Image size 2352x1568. Retinal fundus photograph:
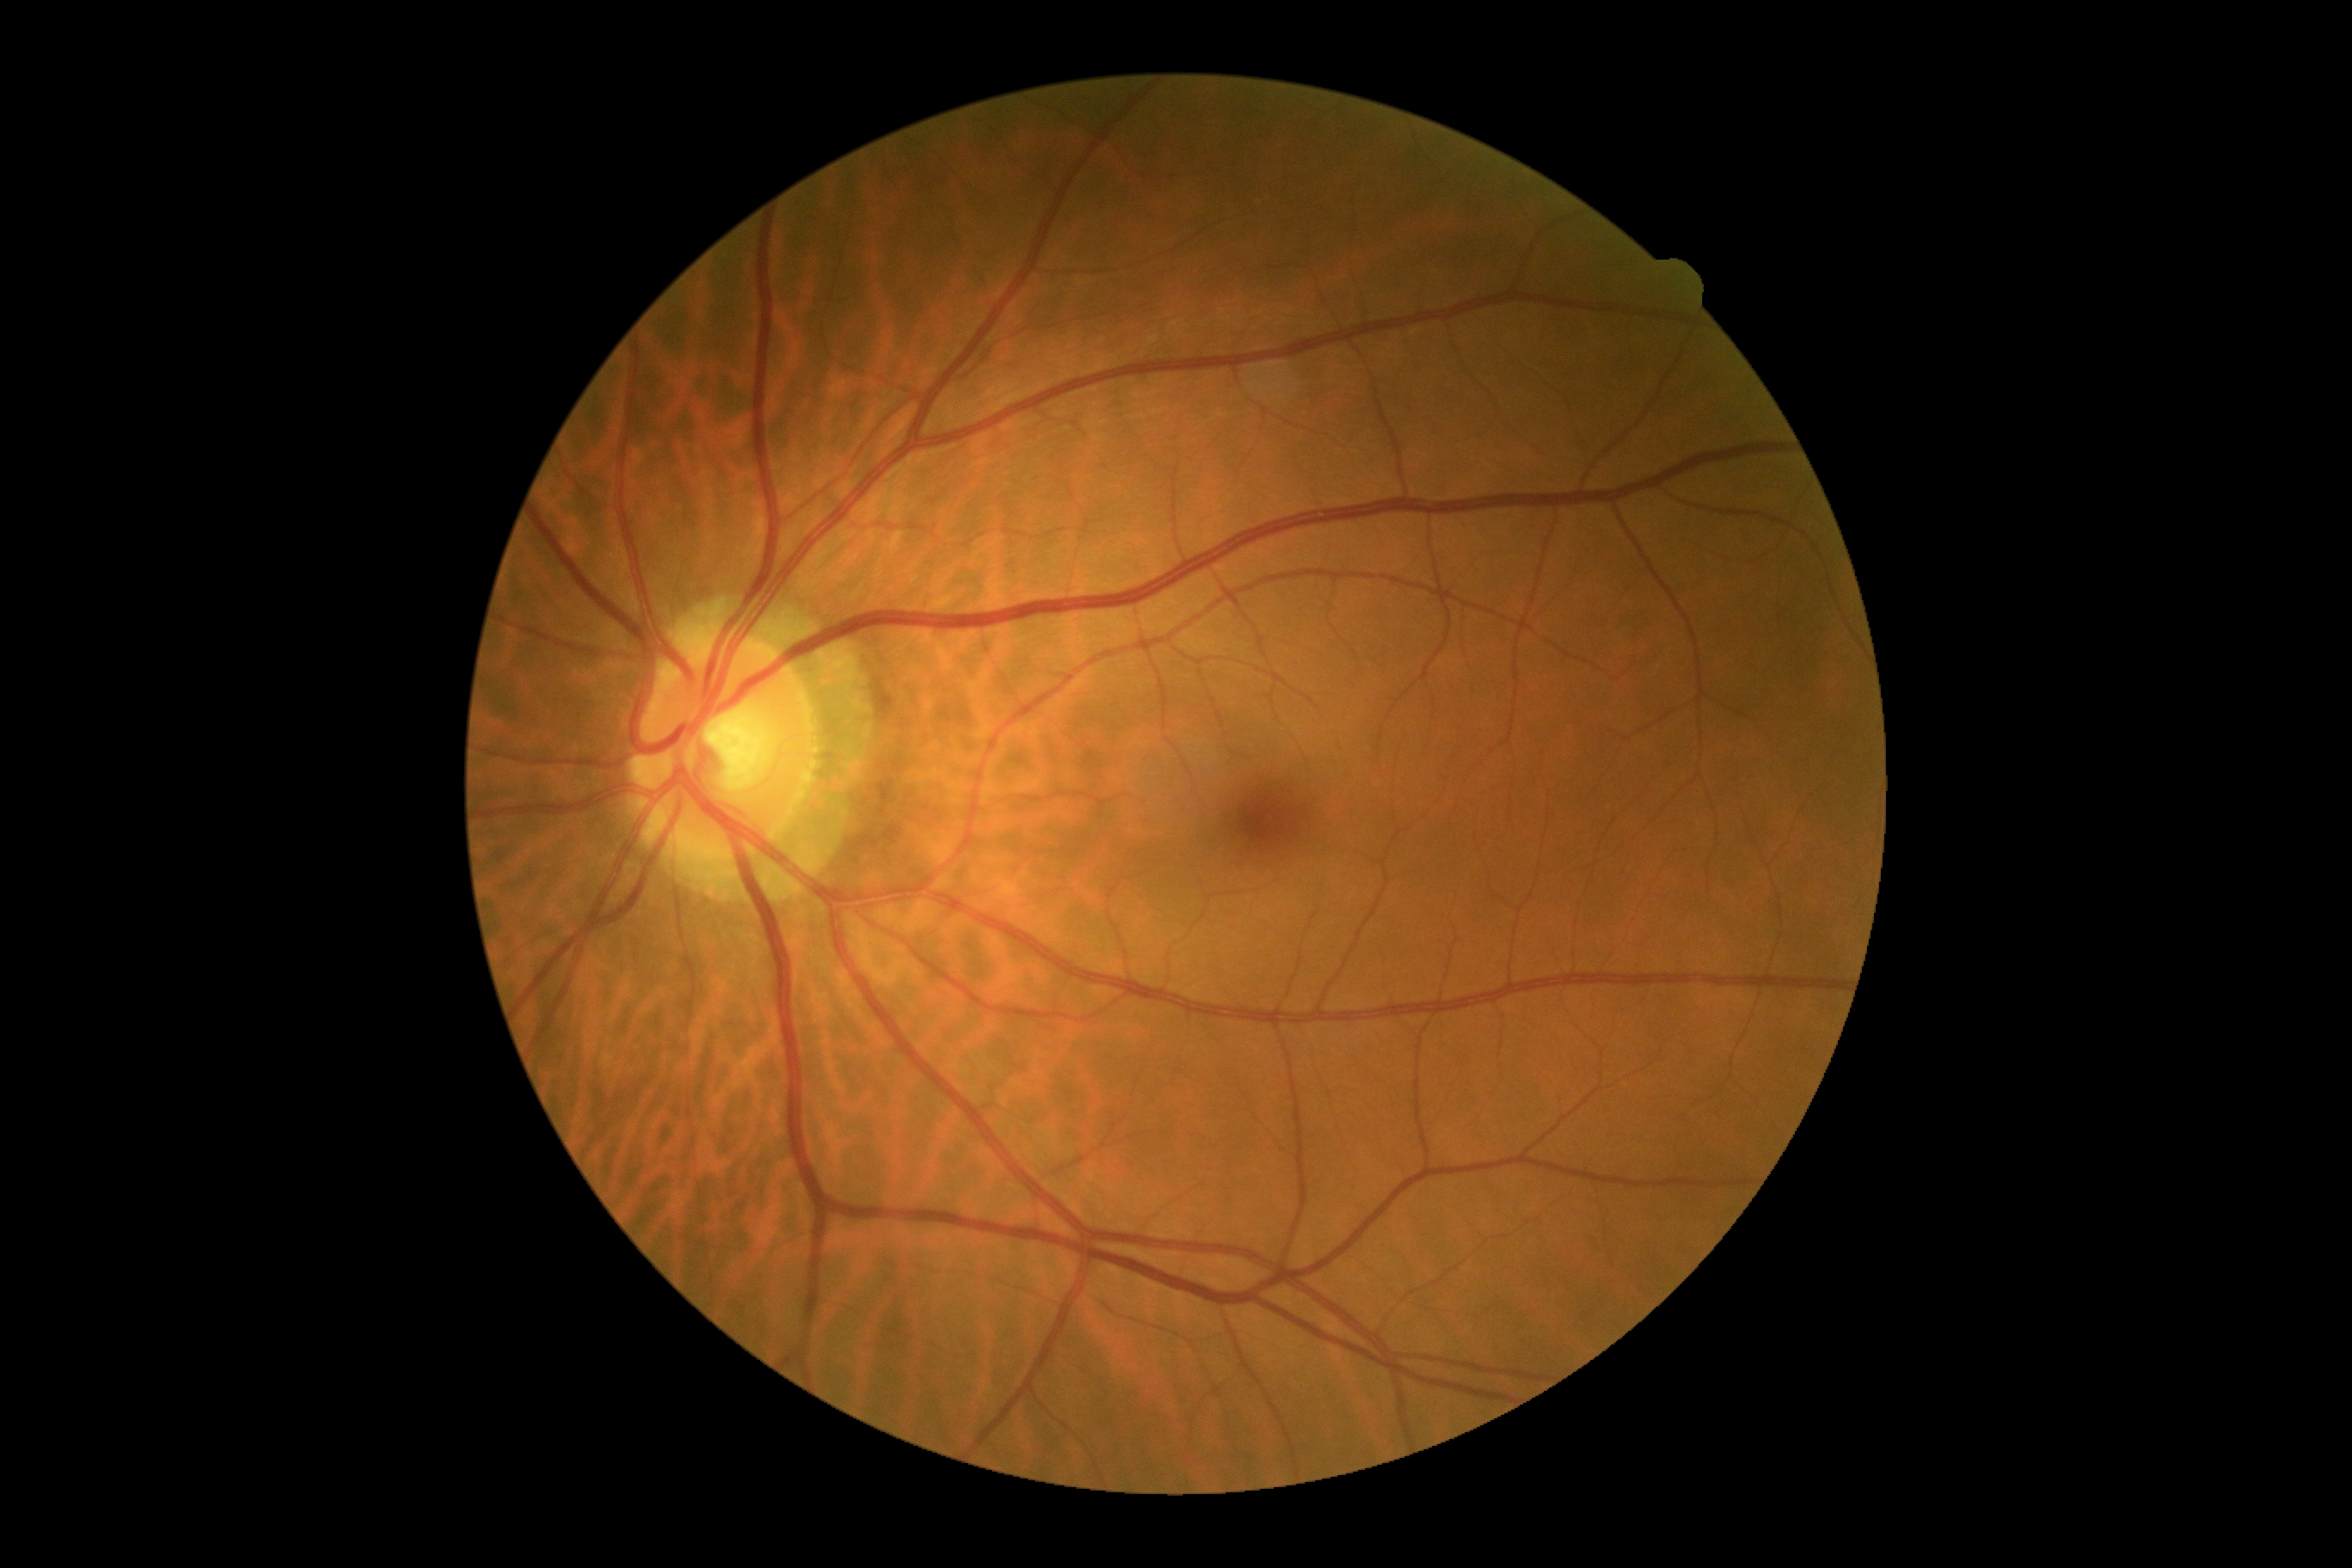 DR grade = 0/4.